Infant wide-field retinal image — 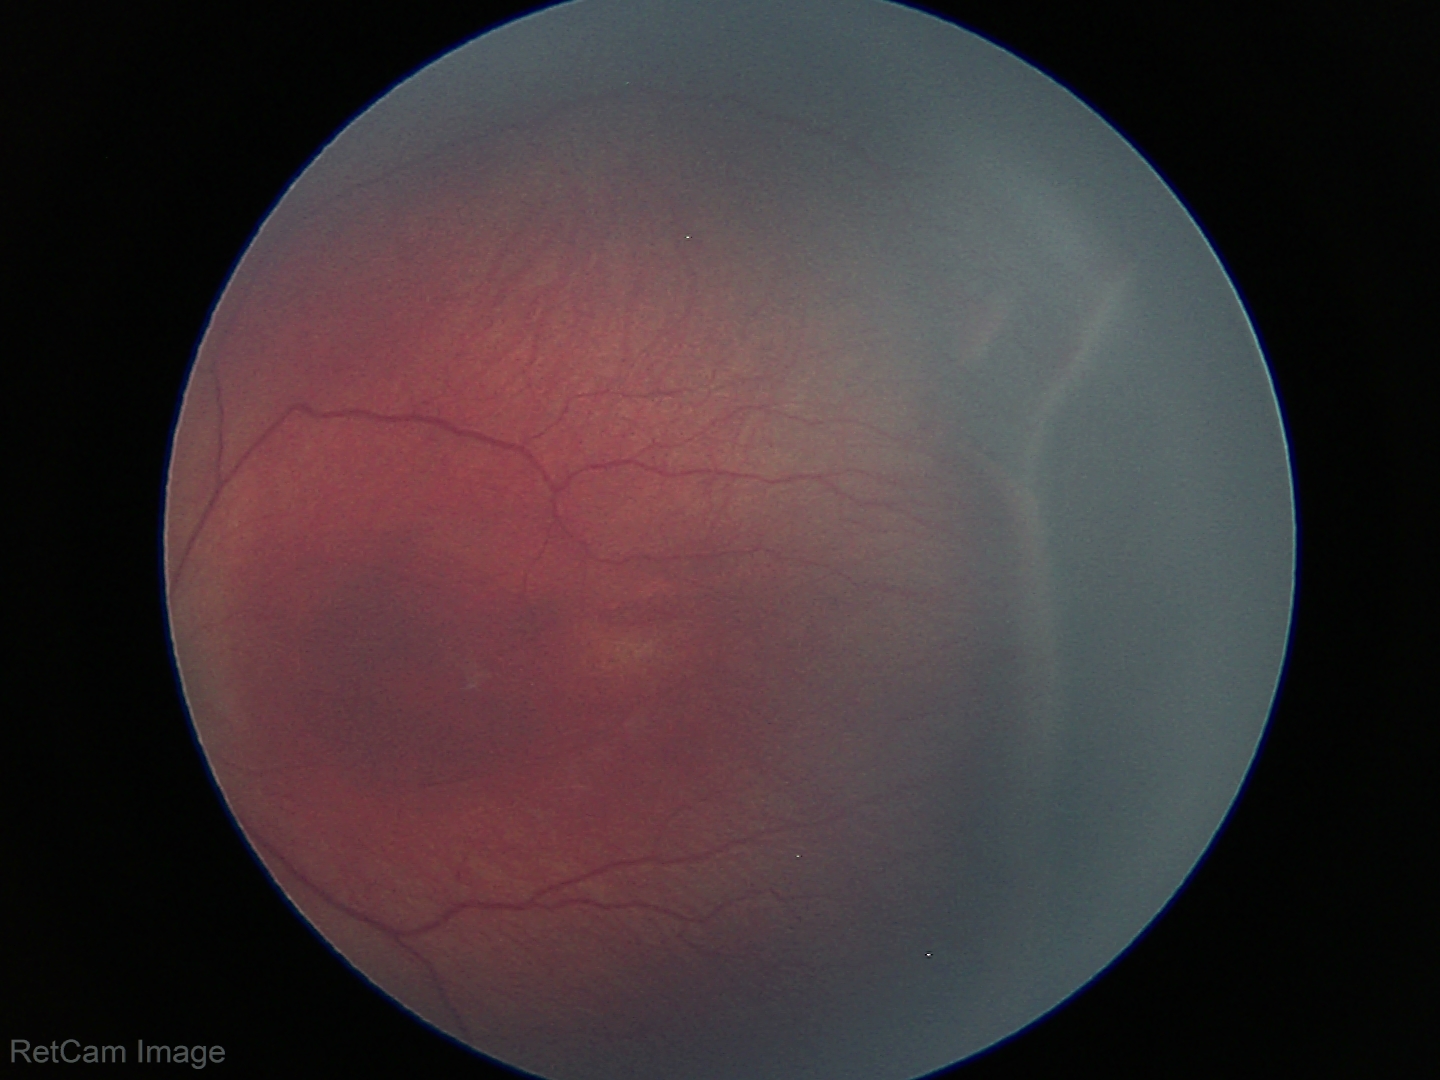
Screening diagnosis = retinopathy of prematurity (ROP) stage 3.